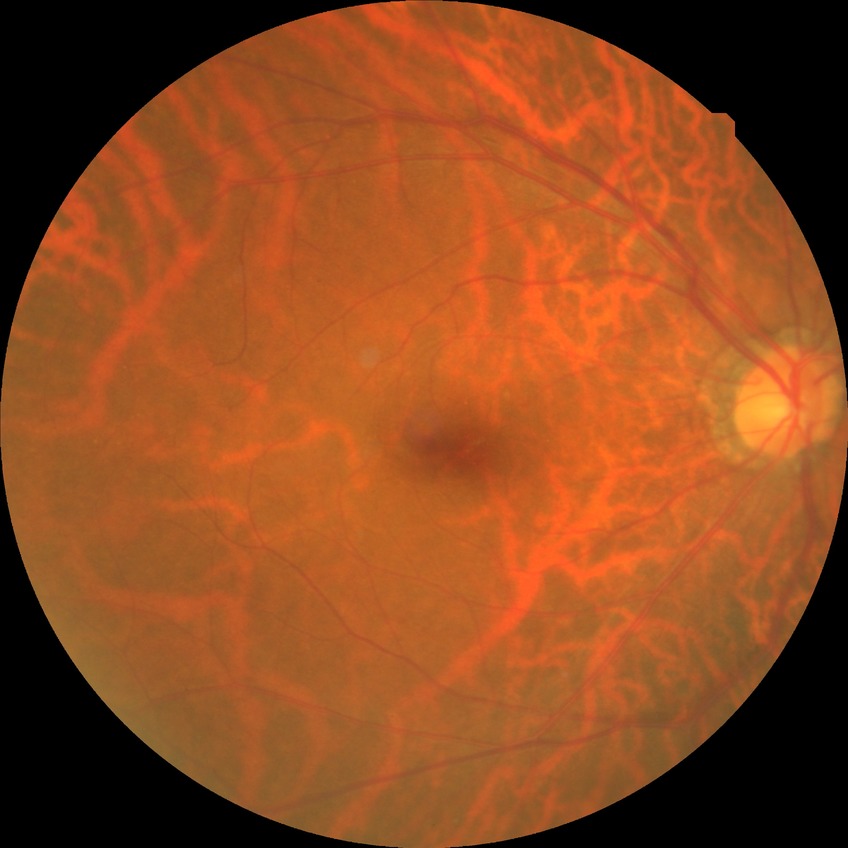

Retinopathy grade: no diabetic retinopathy.